45° field of view, modified Davis grading, image size 848x848.
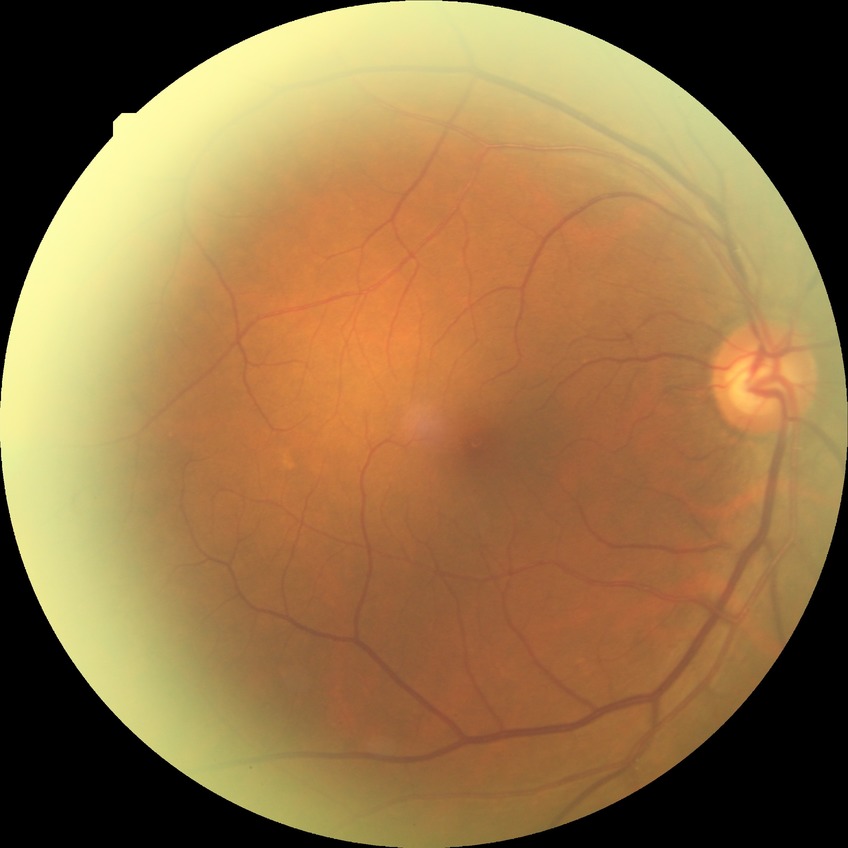

Diabetic retinopathy stage is no diabetic retinopathy.